100° field of view (Phoenix ICON); 1240x1240; pediatric retinal photograph (wide-field):
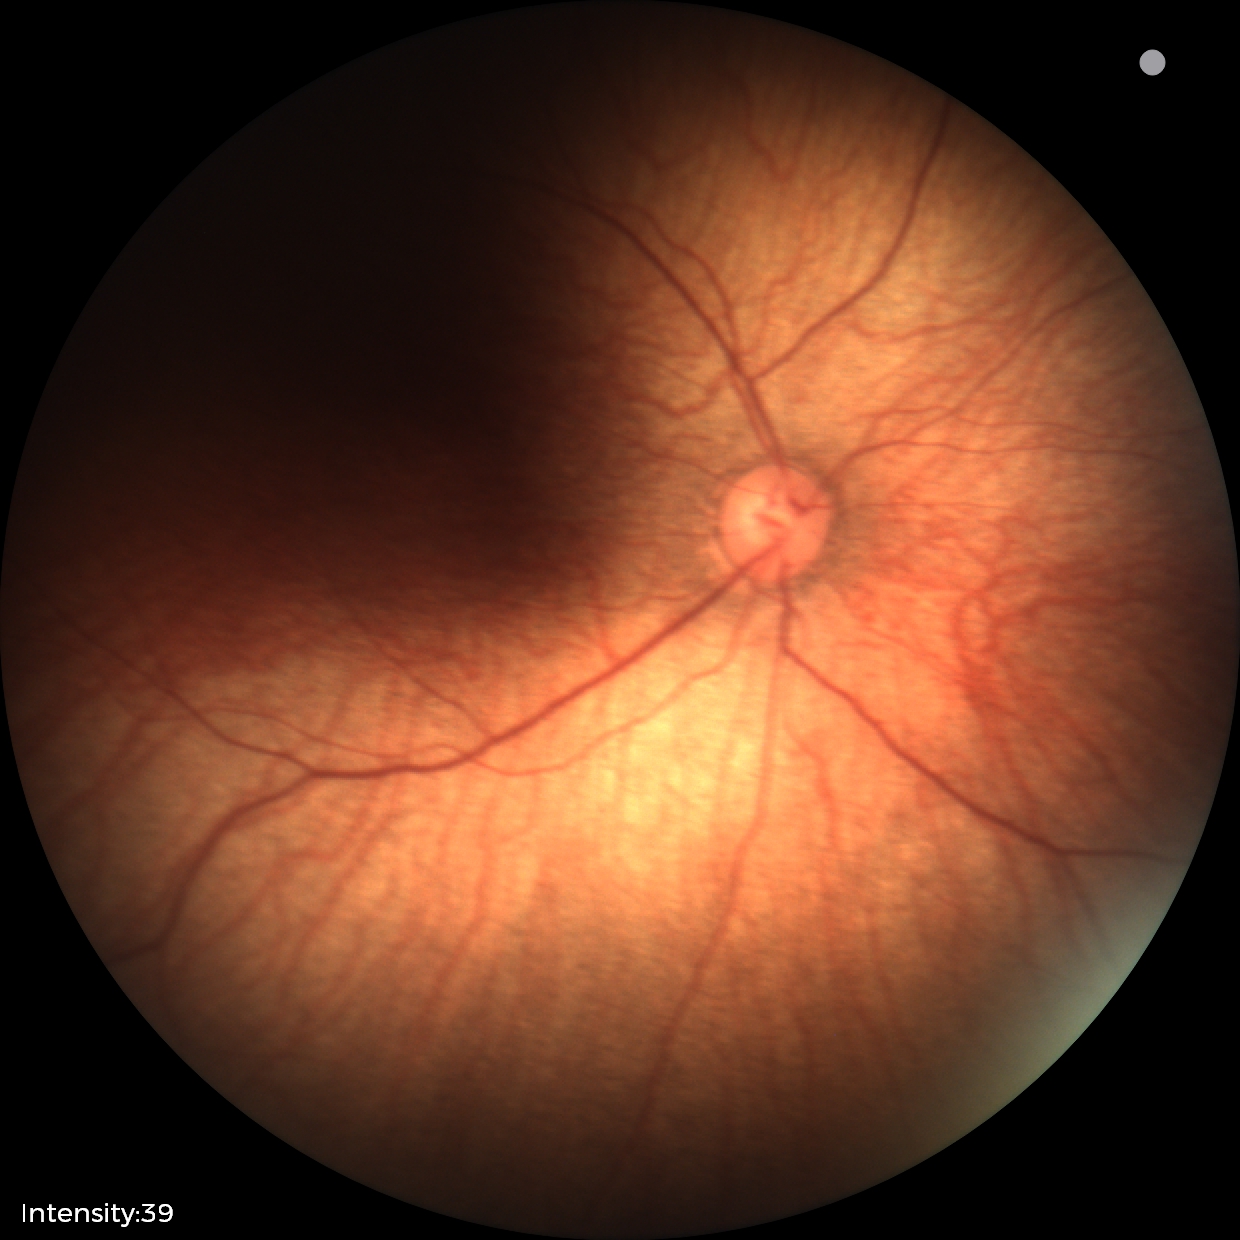

Impression = normal retinal appearance.